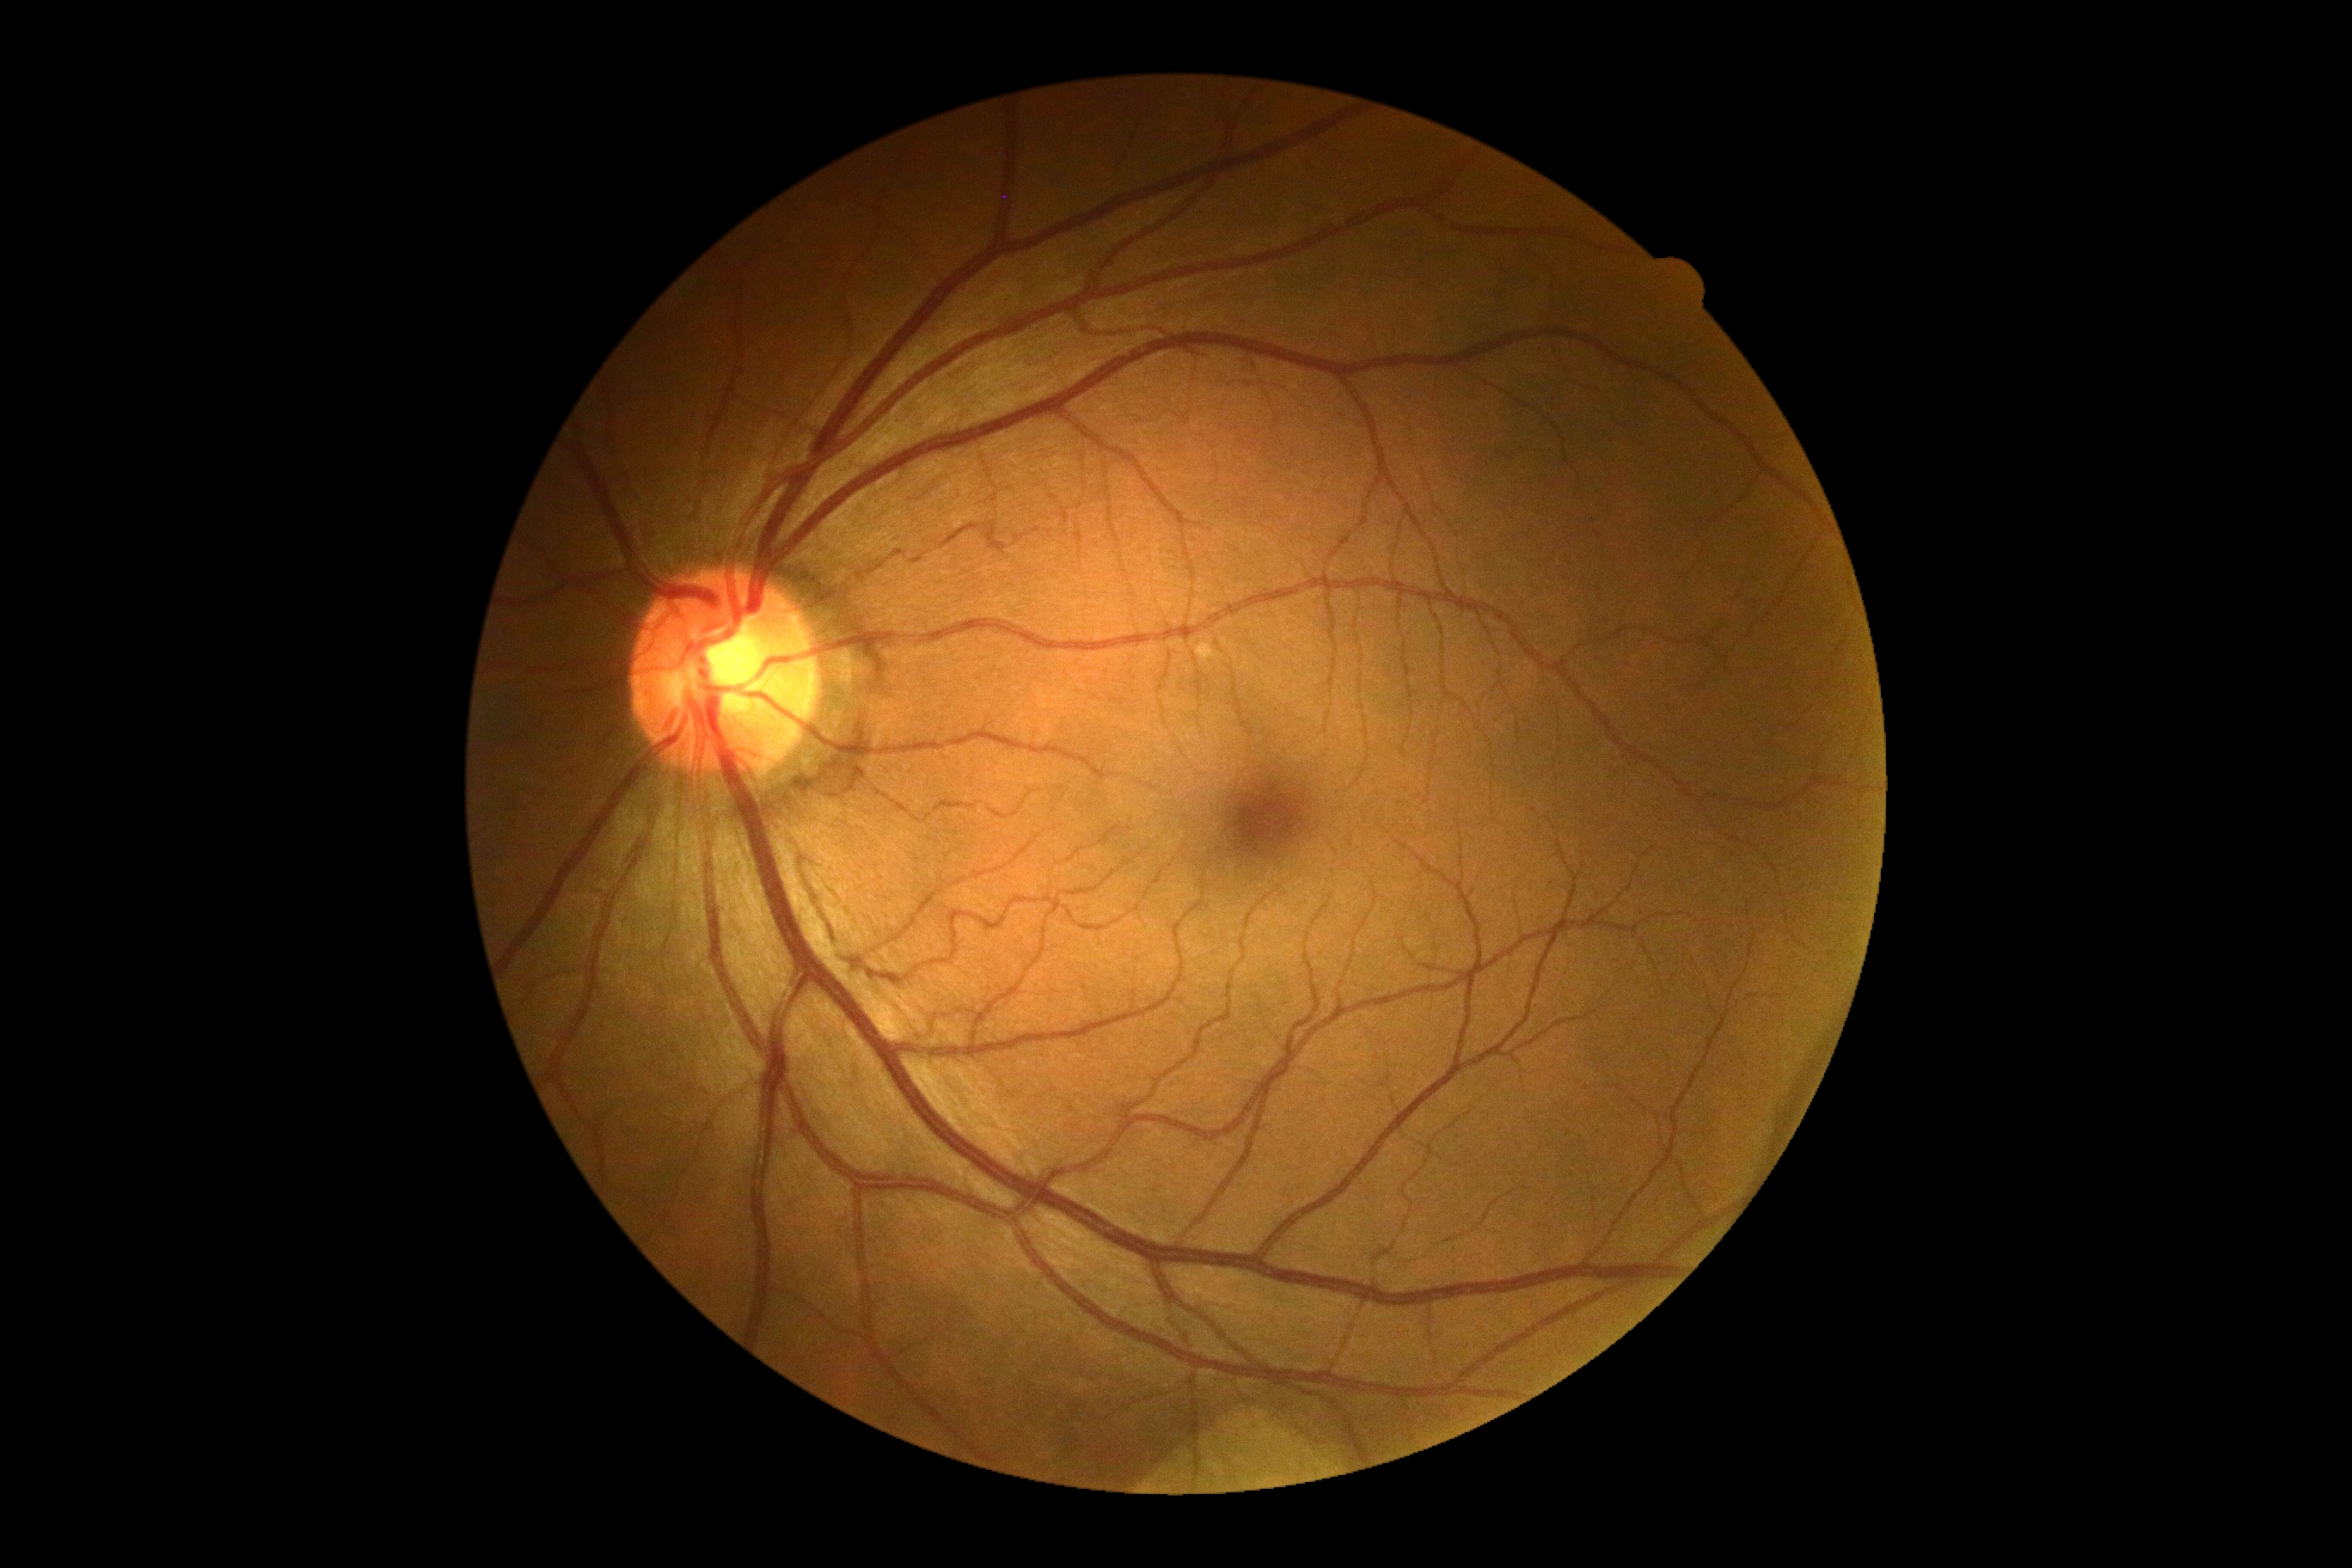 {"dr_grade": "0/4", "dr_impression": "negative for DR"}